45-degree field of view; 2352x1568; CFP — 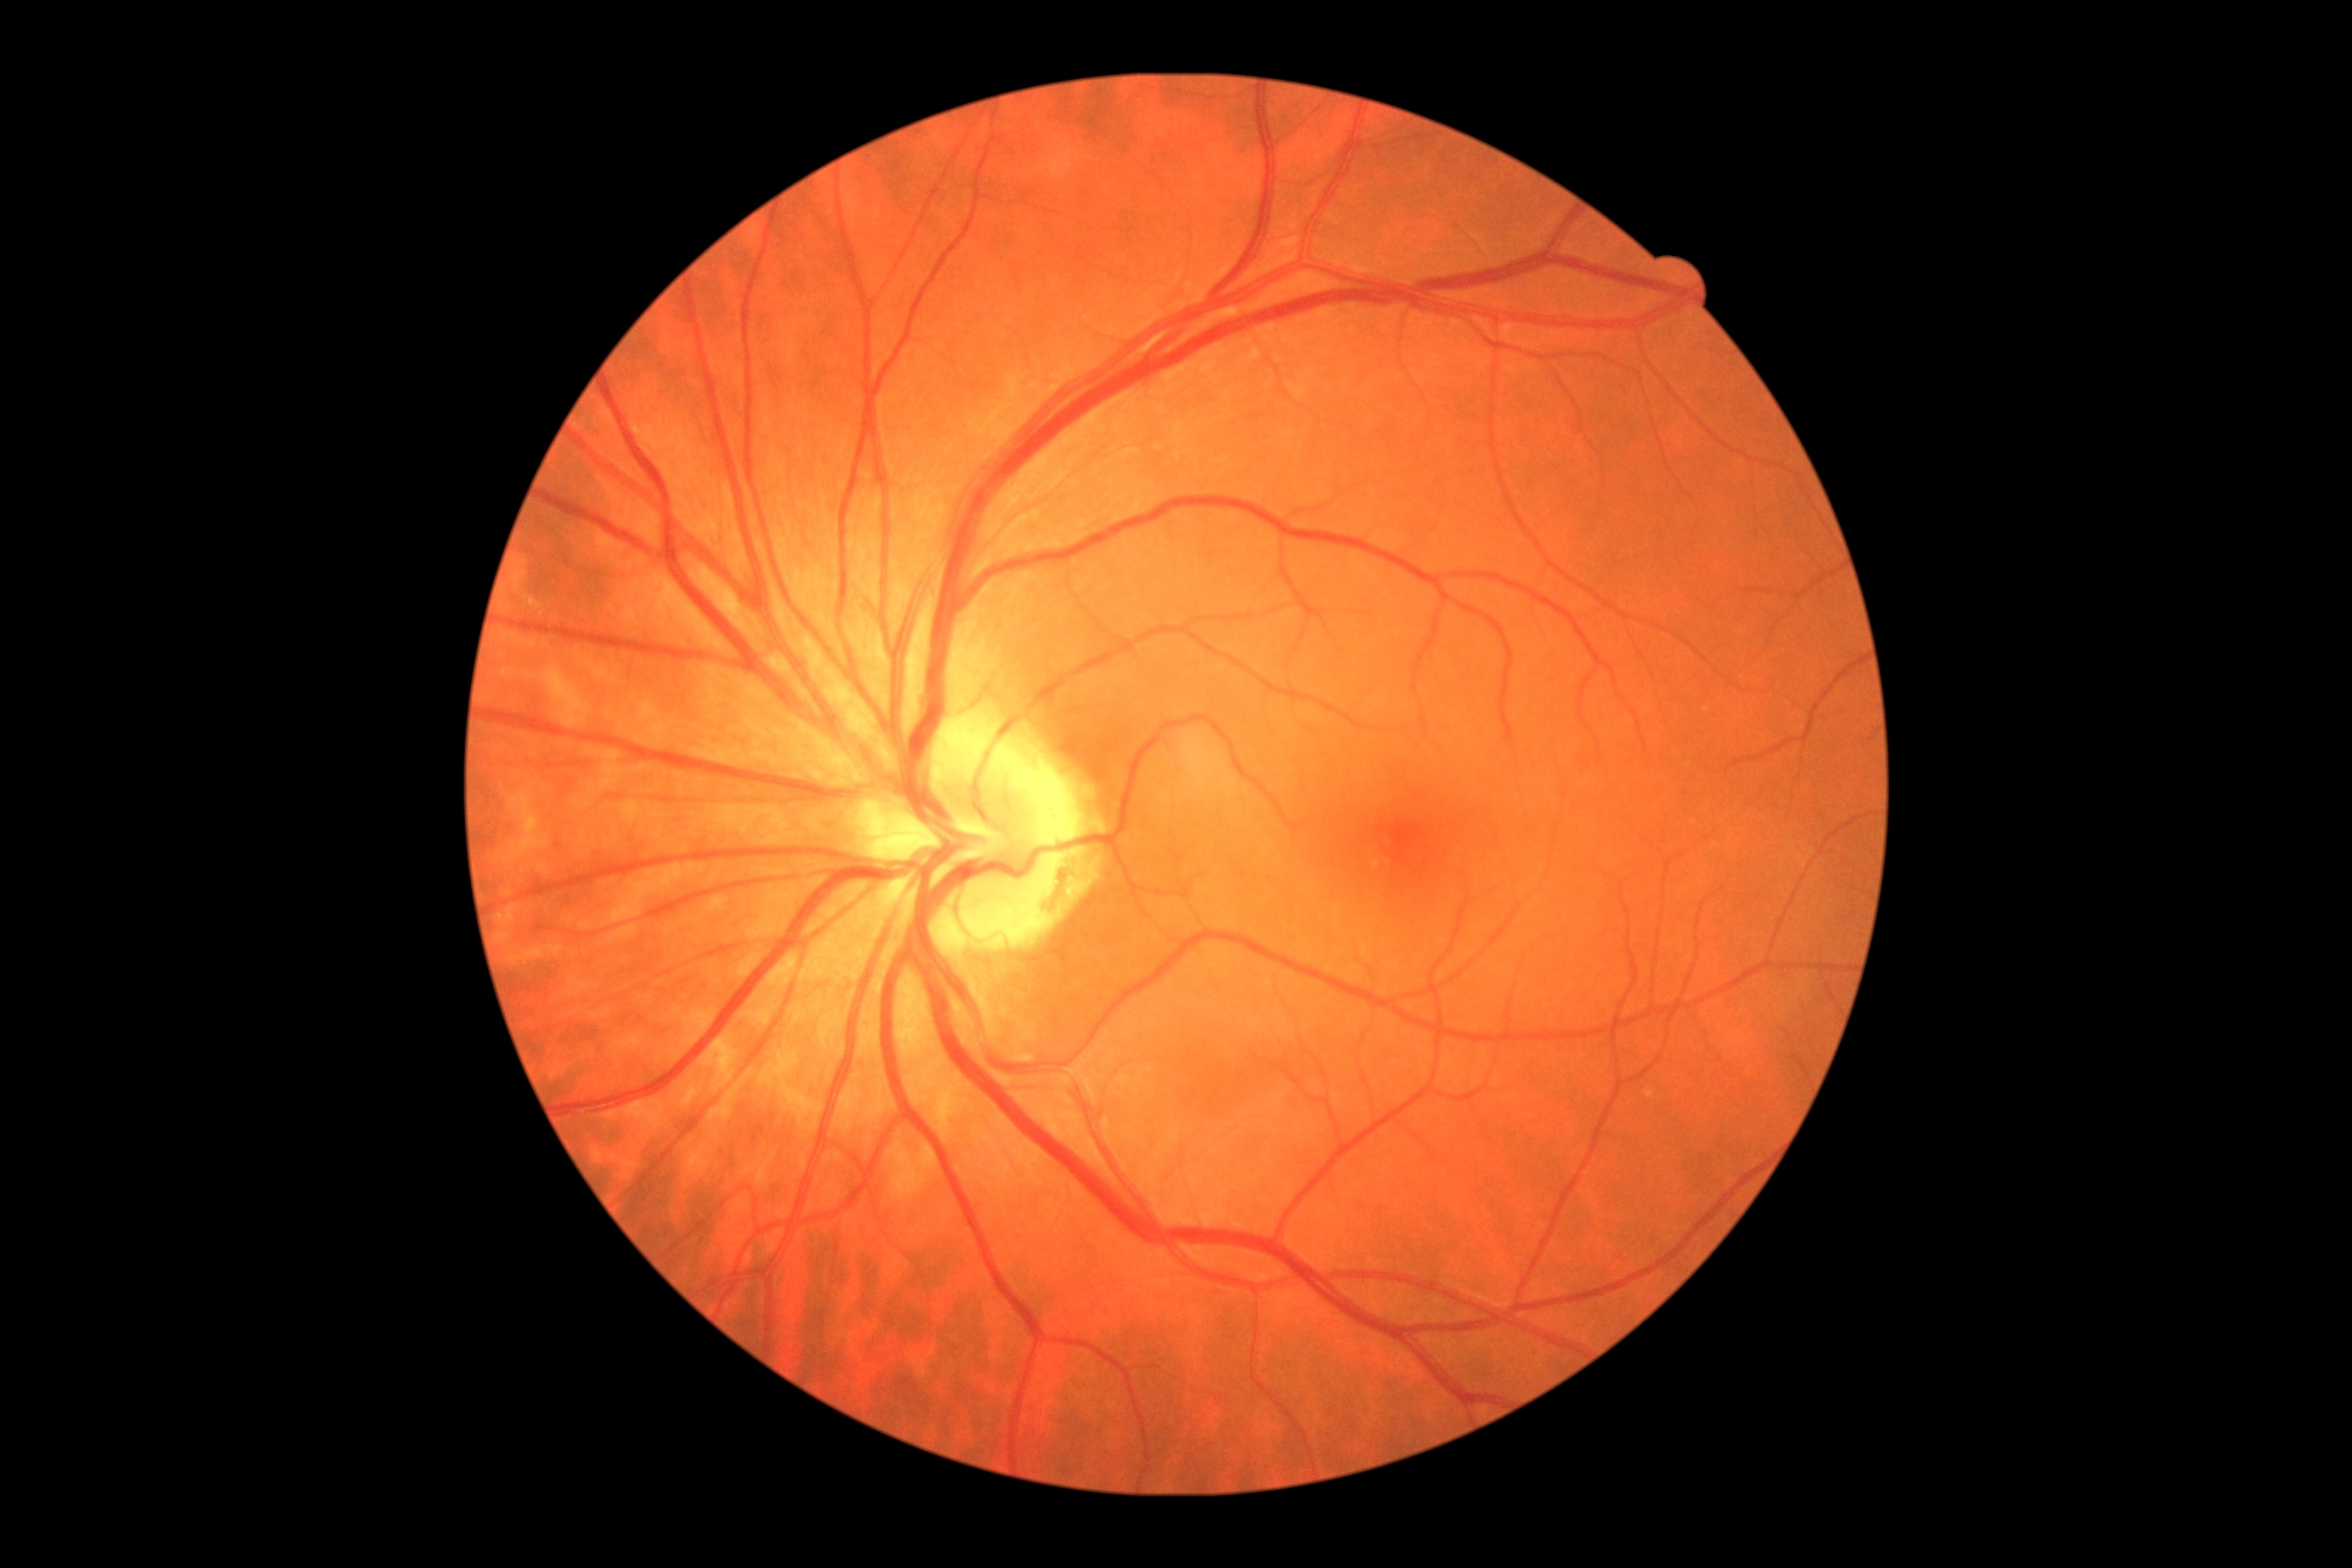
No signs of diabetic retinopathy. Retinopathy grade is 0.